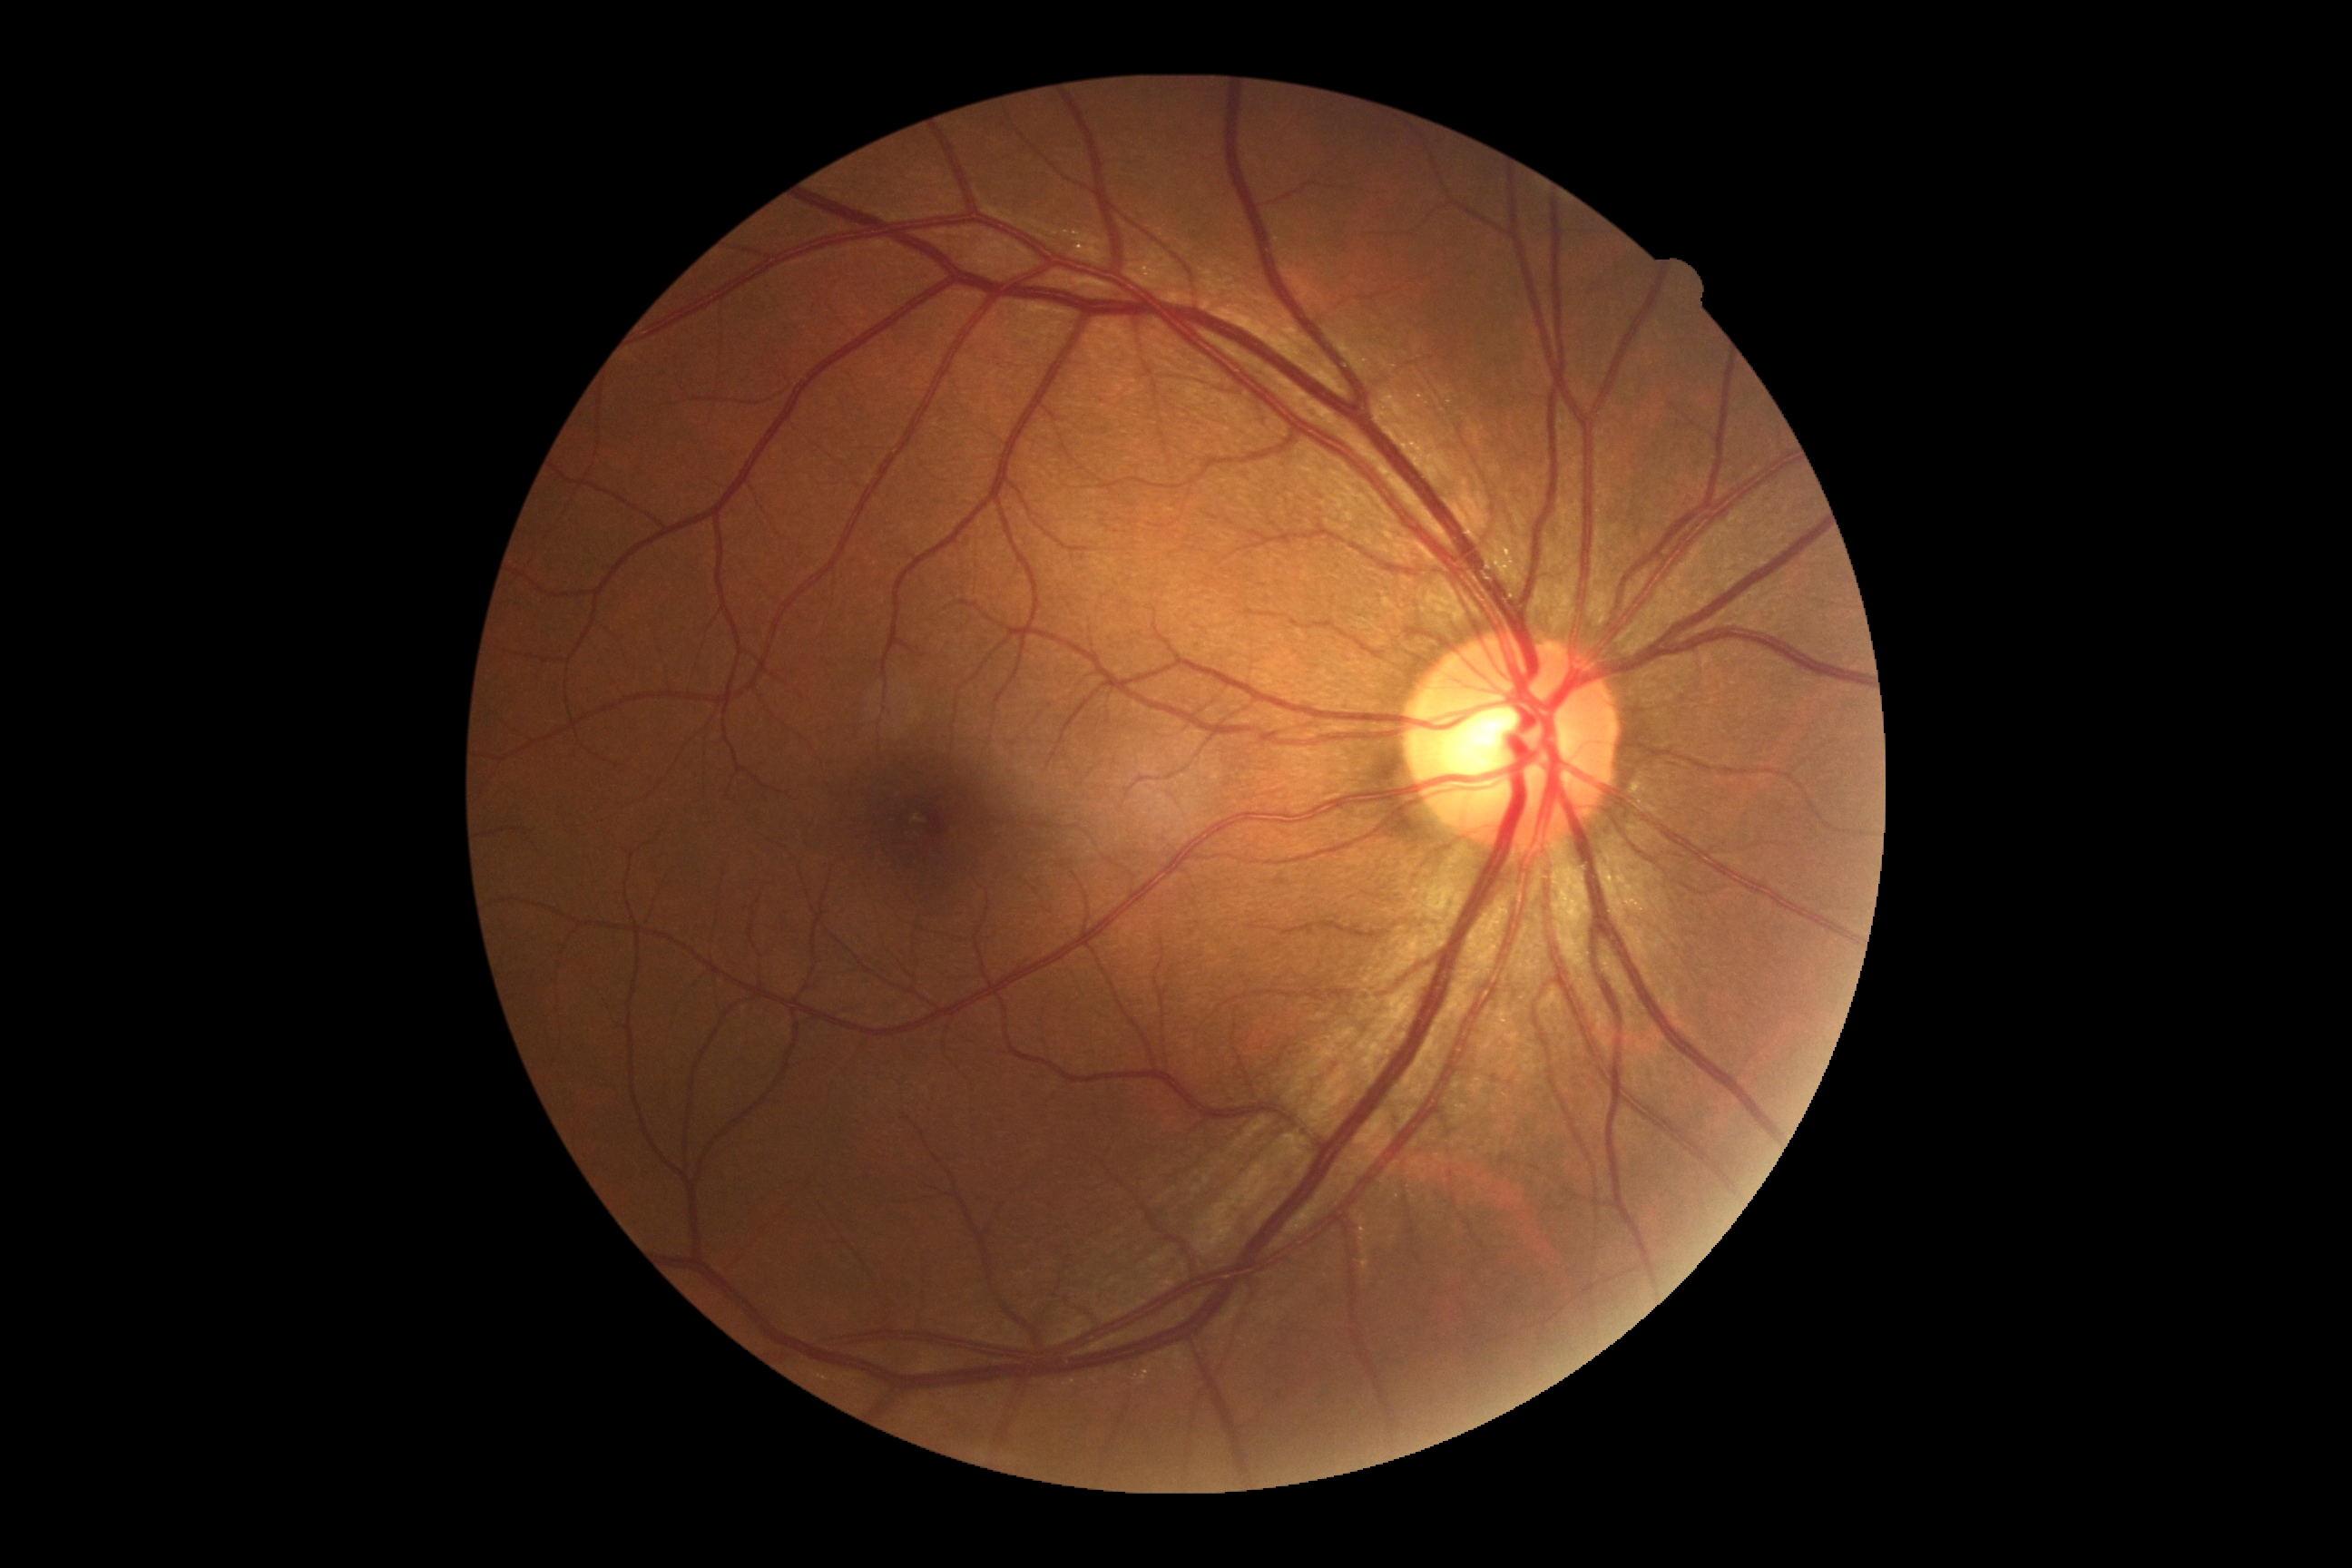

DR stage = grade 0 — no visible signs of diabetic retinopathy | DR impression = no signs of DR.